Color fundus image, 45-degree field of view
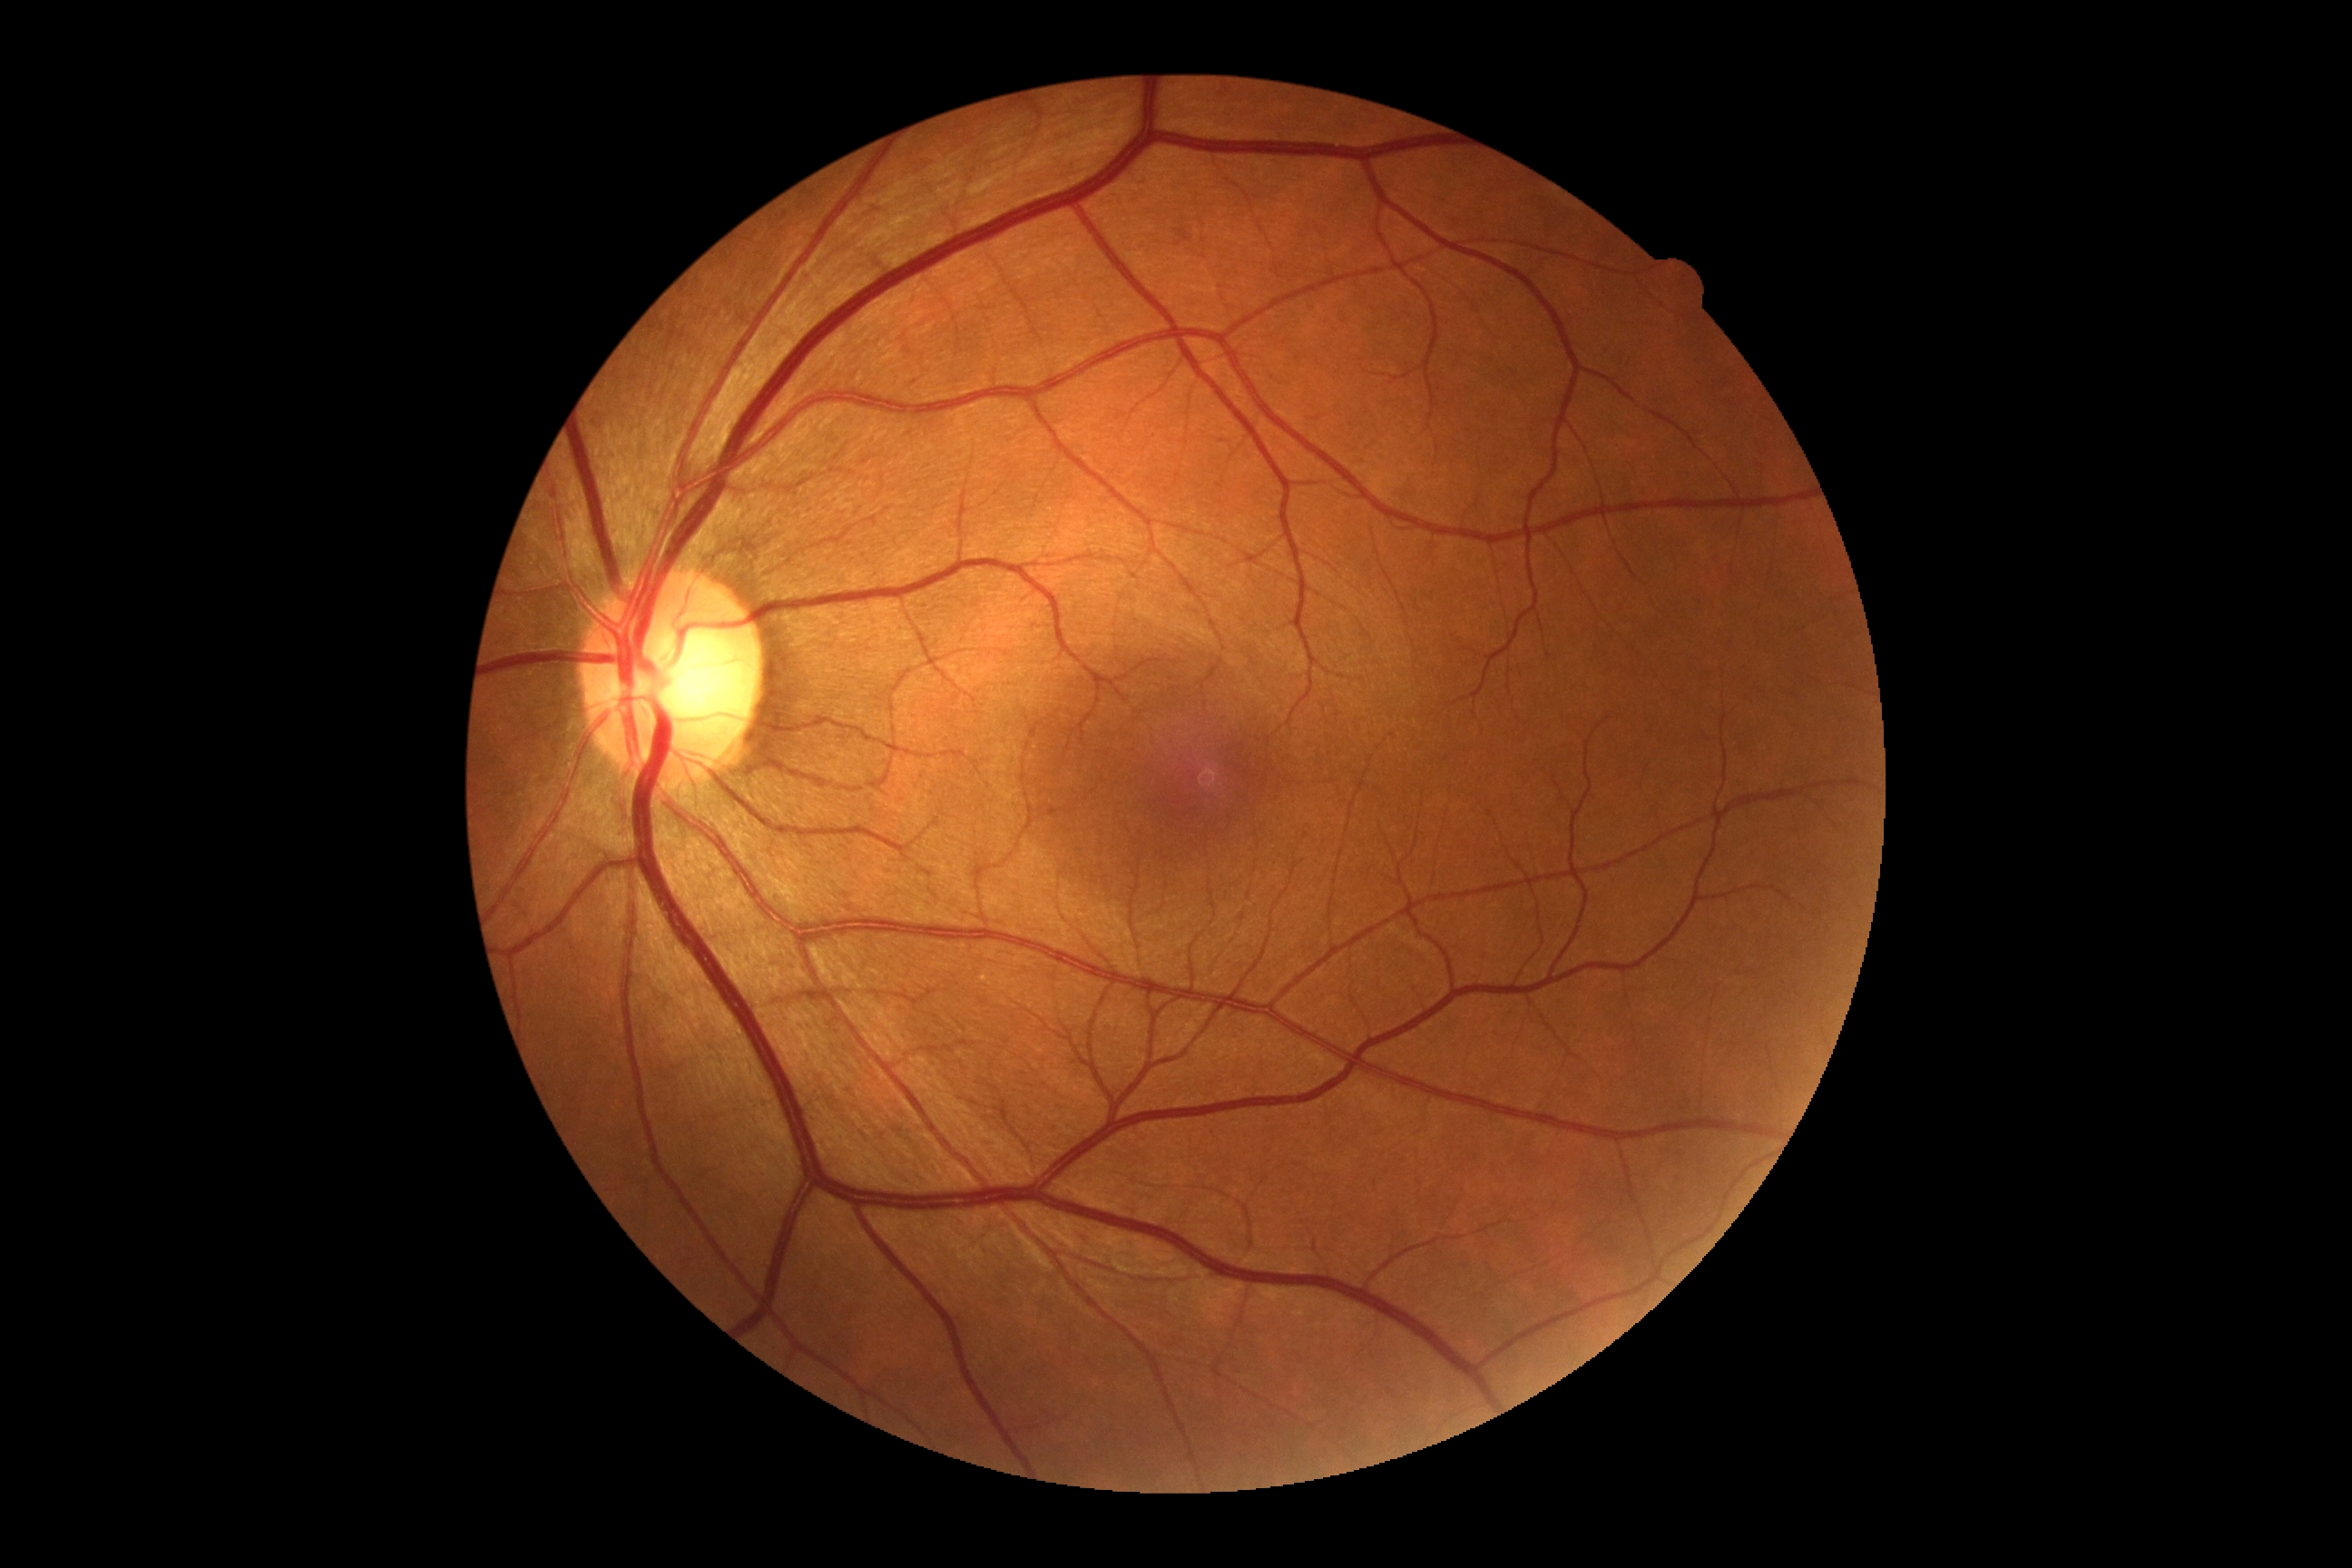

{"dr_grade": "0"}